45° FOV.
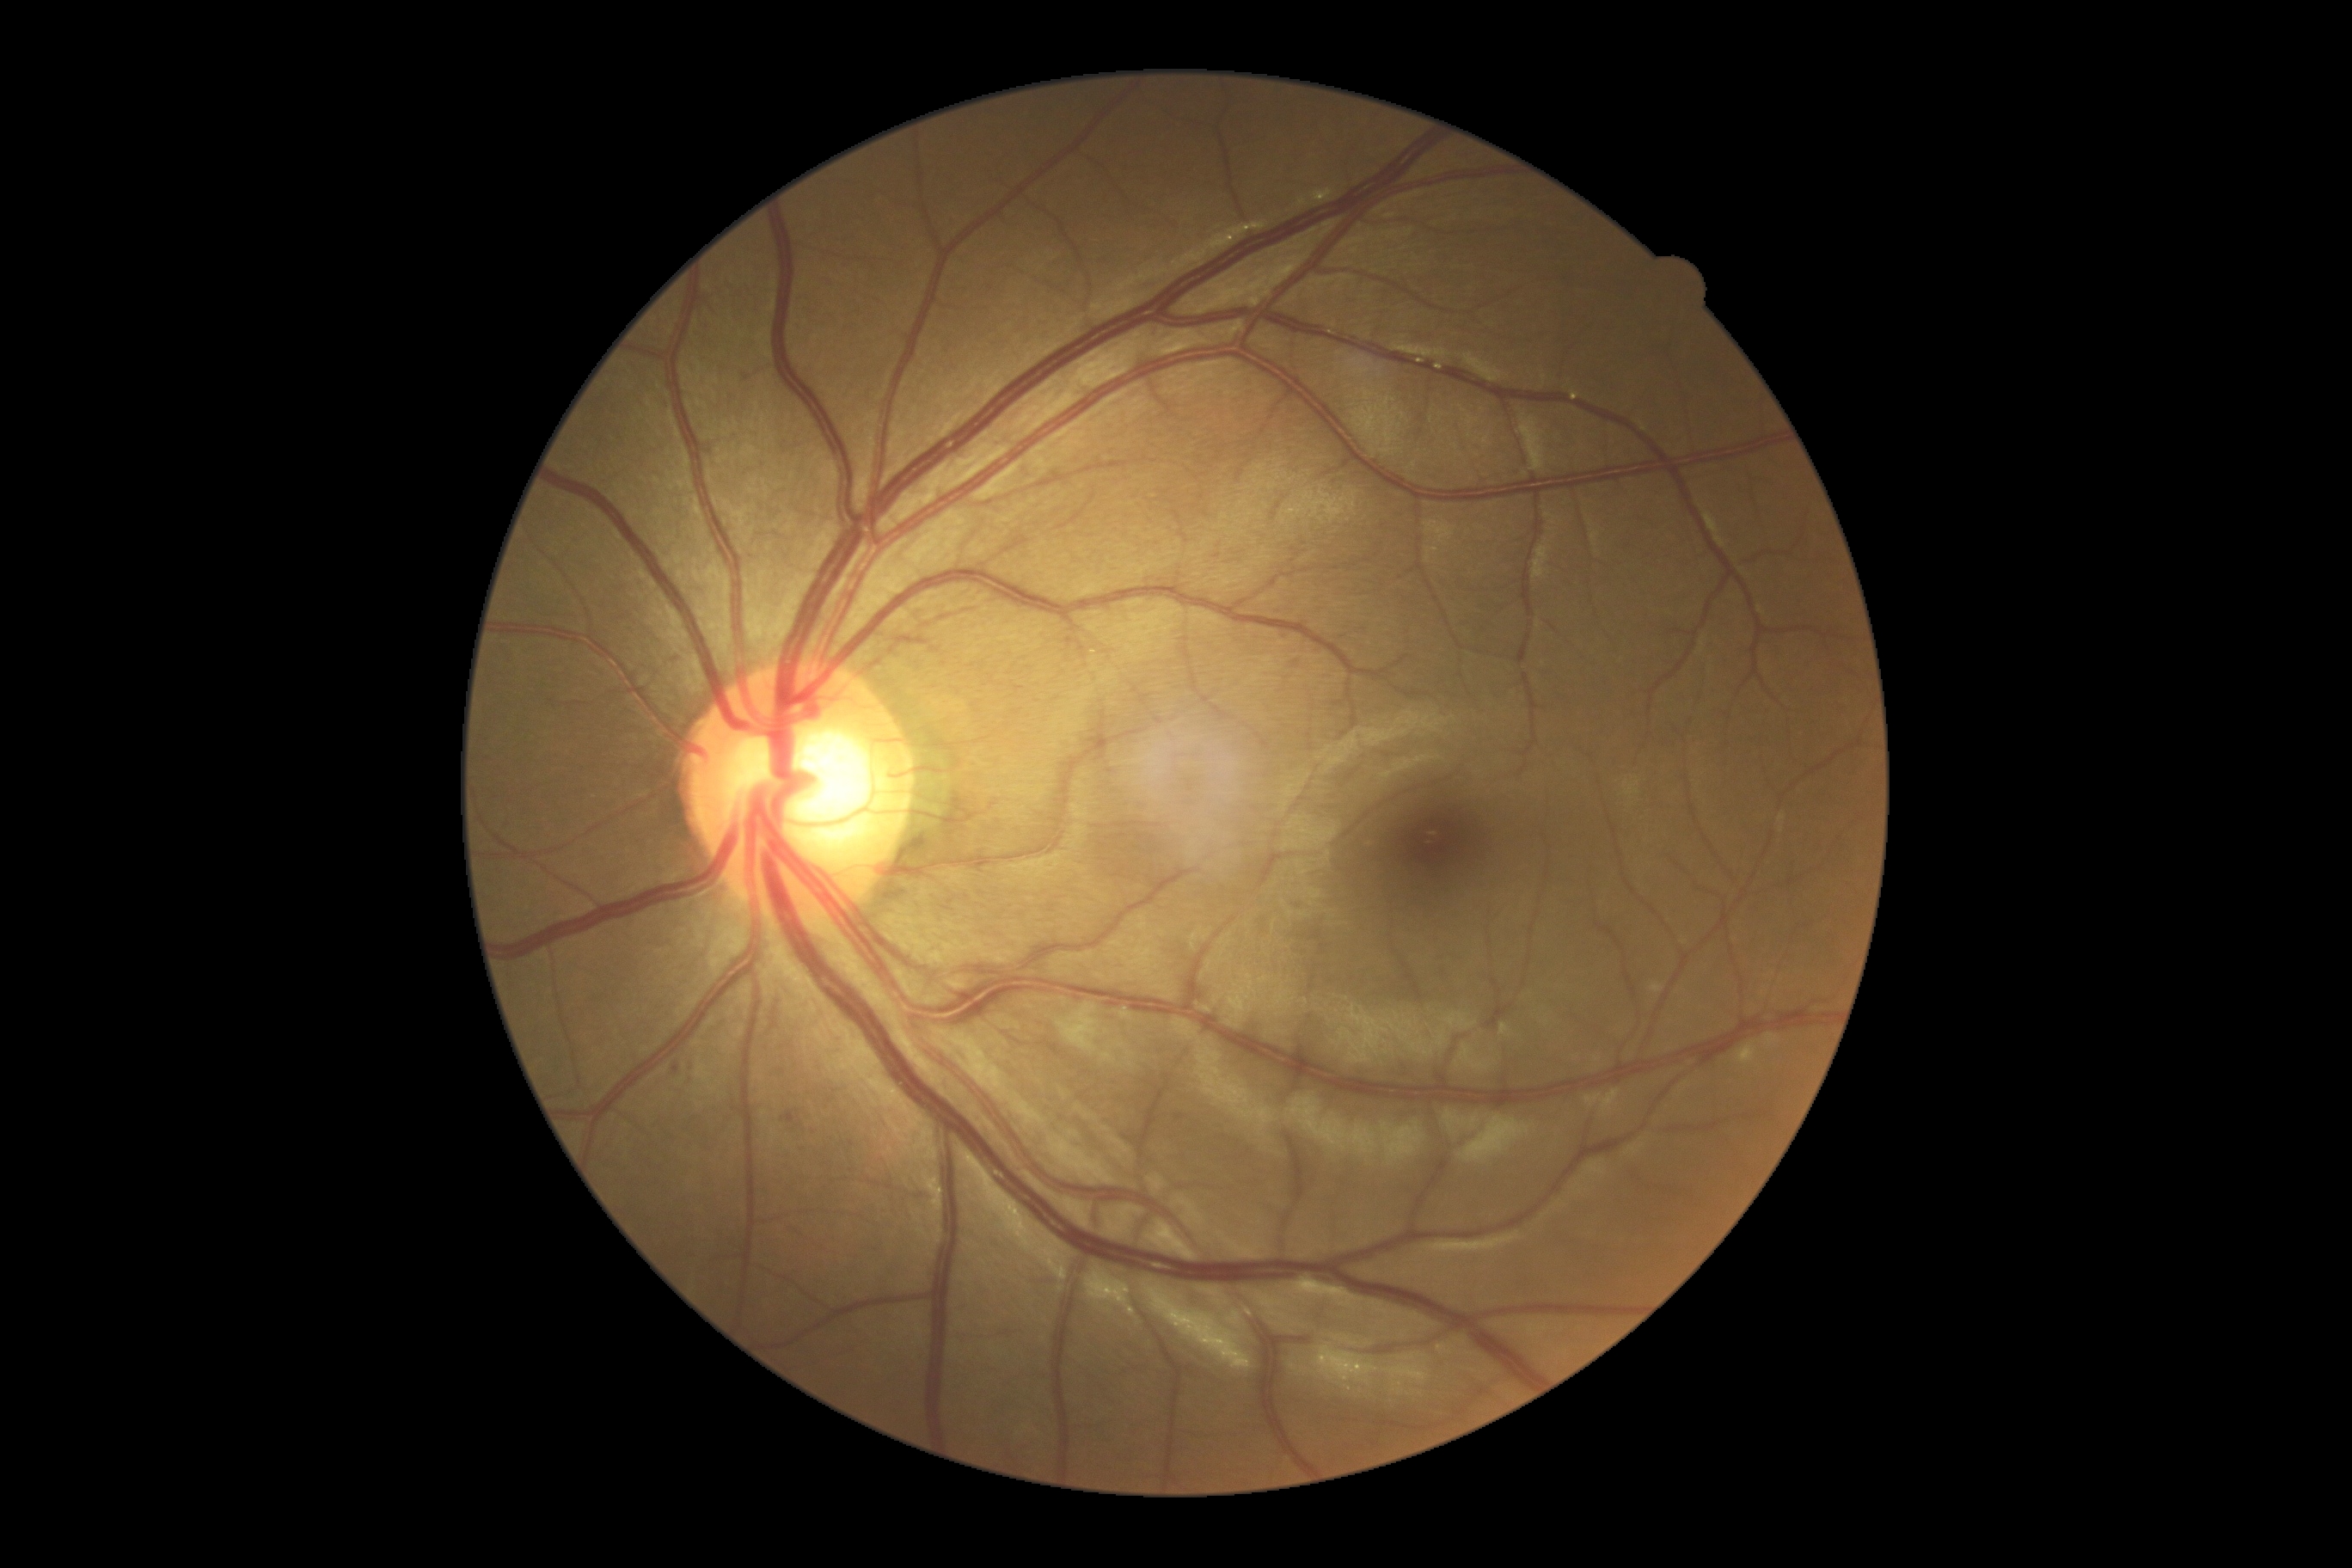

Retinopathy grade: moderate NPDR (2).